Camera: NIDEK AFC-230; 848 by 848 pixels; nonmydriatic fundus photograph; retinal fundus photograph — 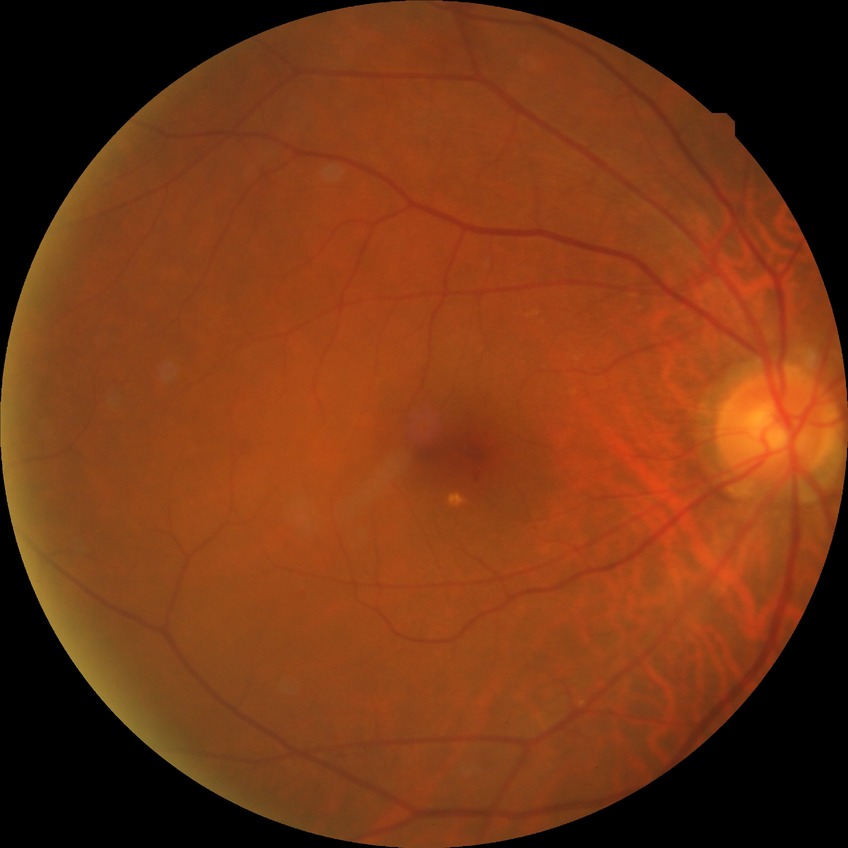
Findings:
- diabetic retinopathy (DR) — no diabetic retinopathy (NDR)